CFP:
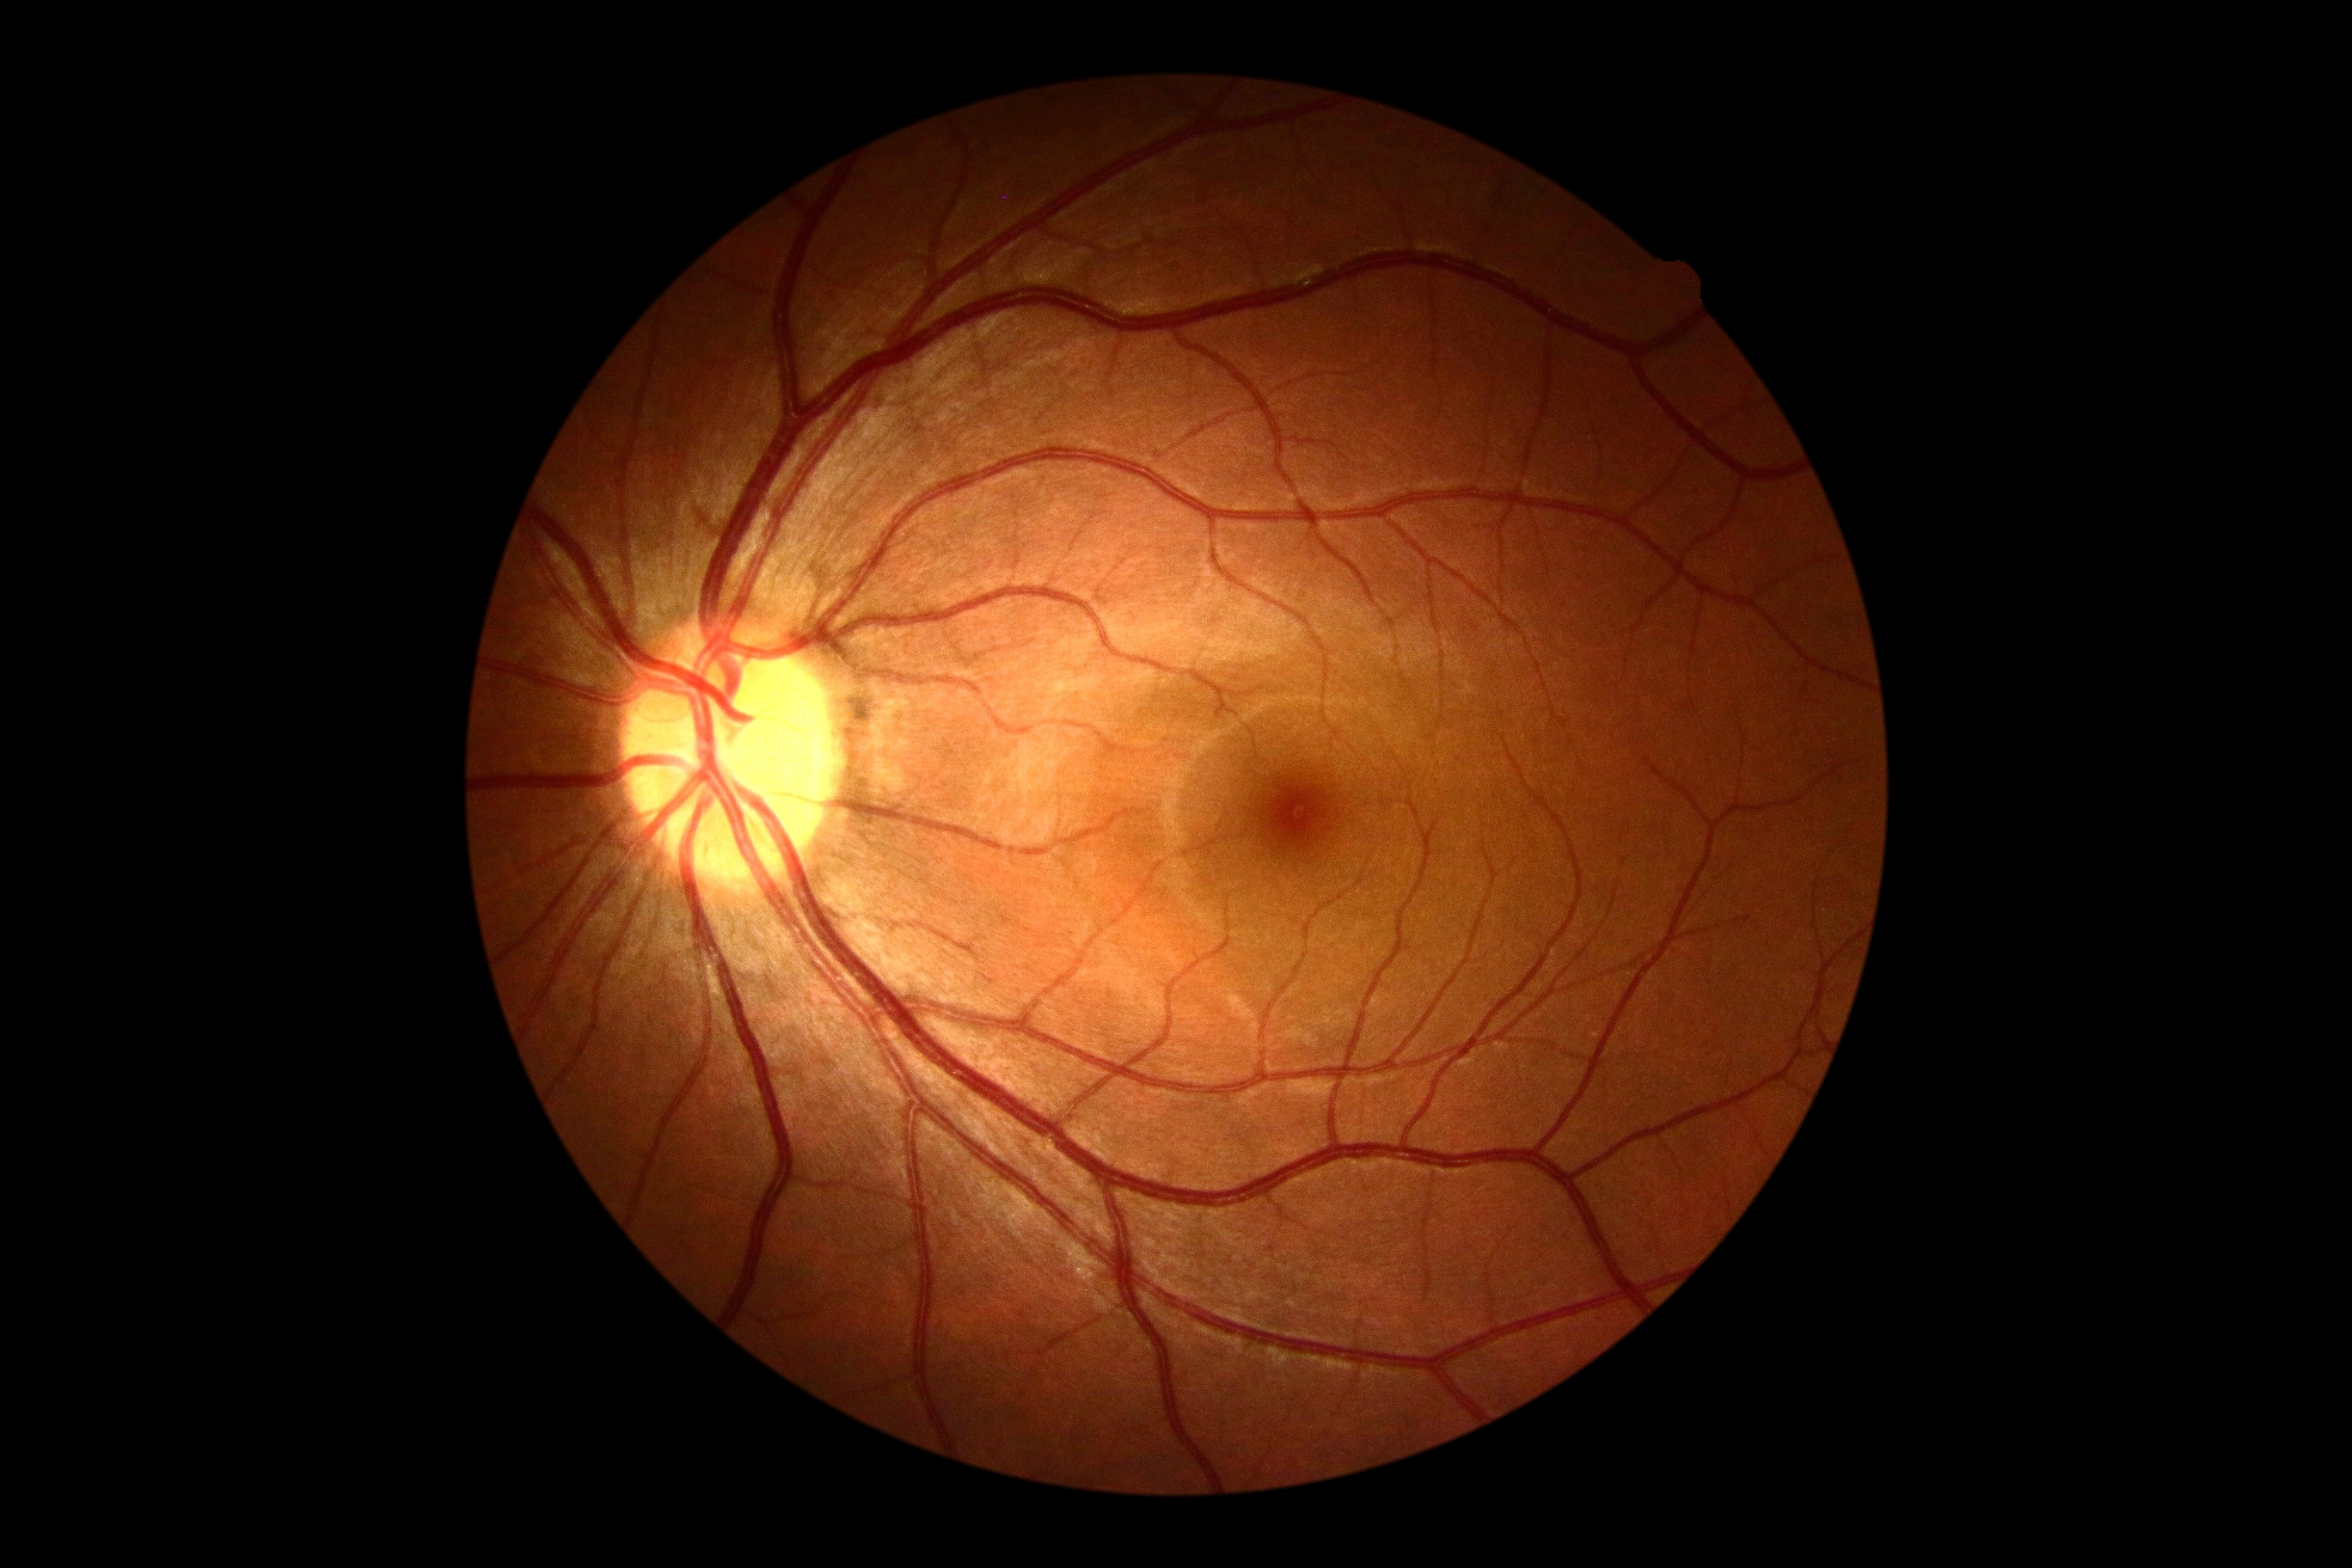
DR grade: 0 (no apparent retinopathy).